NIDEK AFC-230. 45-degree field of view. Image size 848x848. Nonmydriatic fundus photograph: 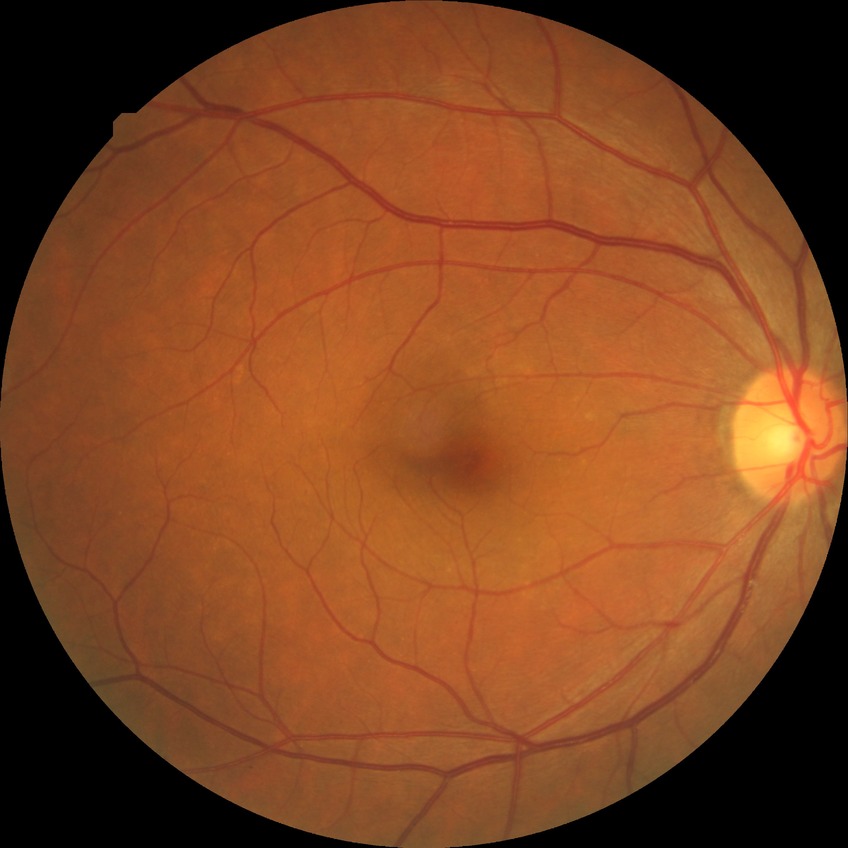
Diabetic retinopathy stage is no diabetic retinopathy.